Wide-field fundus photograph from neonatal ROP screening; 640 x 480 pixels — 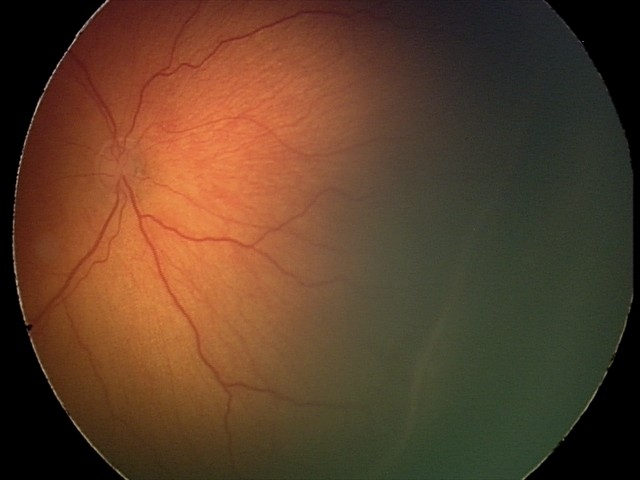
Plus disease absent. Series diagnosed as ROP stage 2.